1240x1240; camera: Phoenix ICON (100° FOV); wide-field contact fundus photograph of an infant — 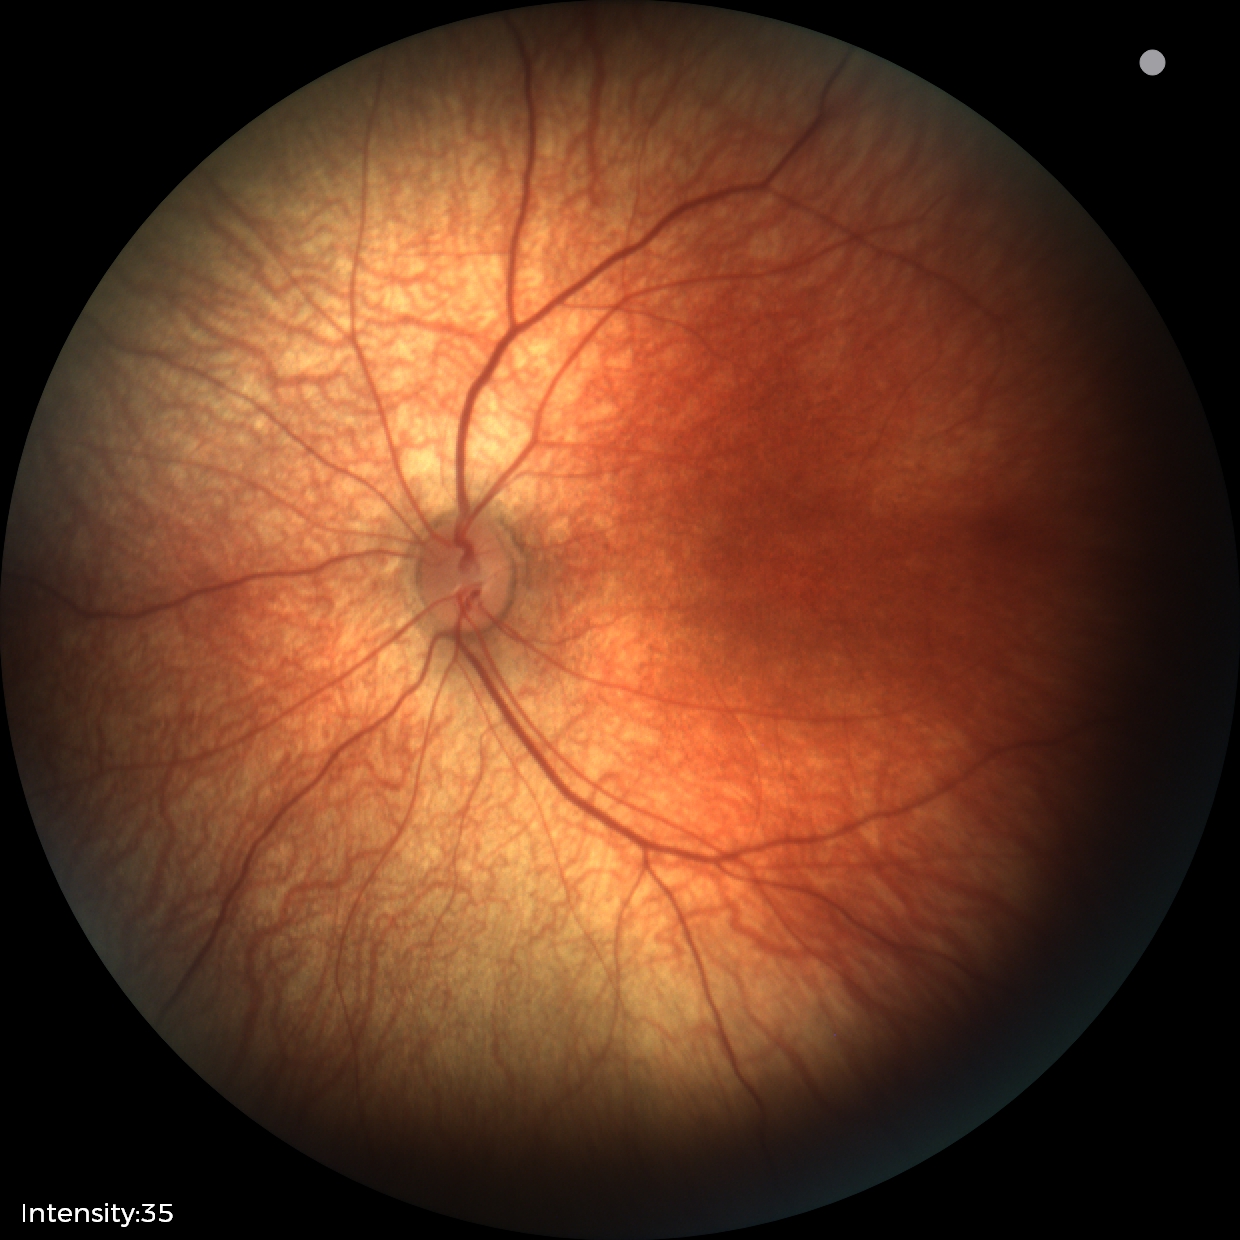

Finding: physiological.